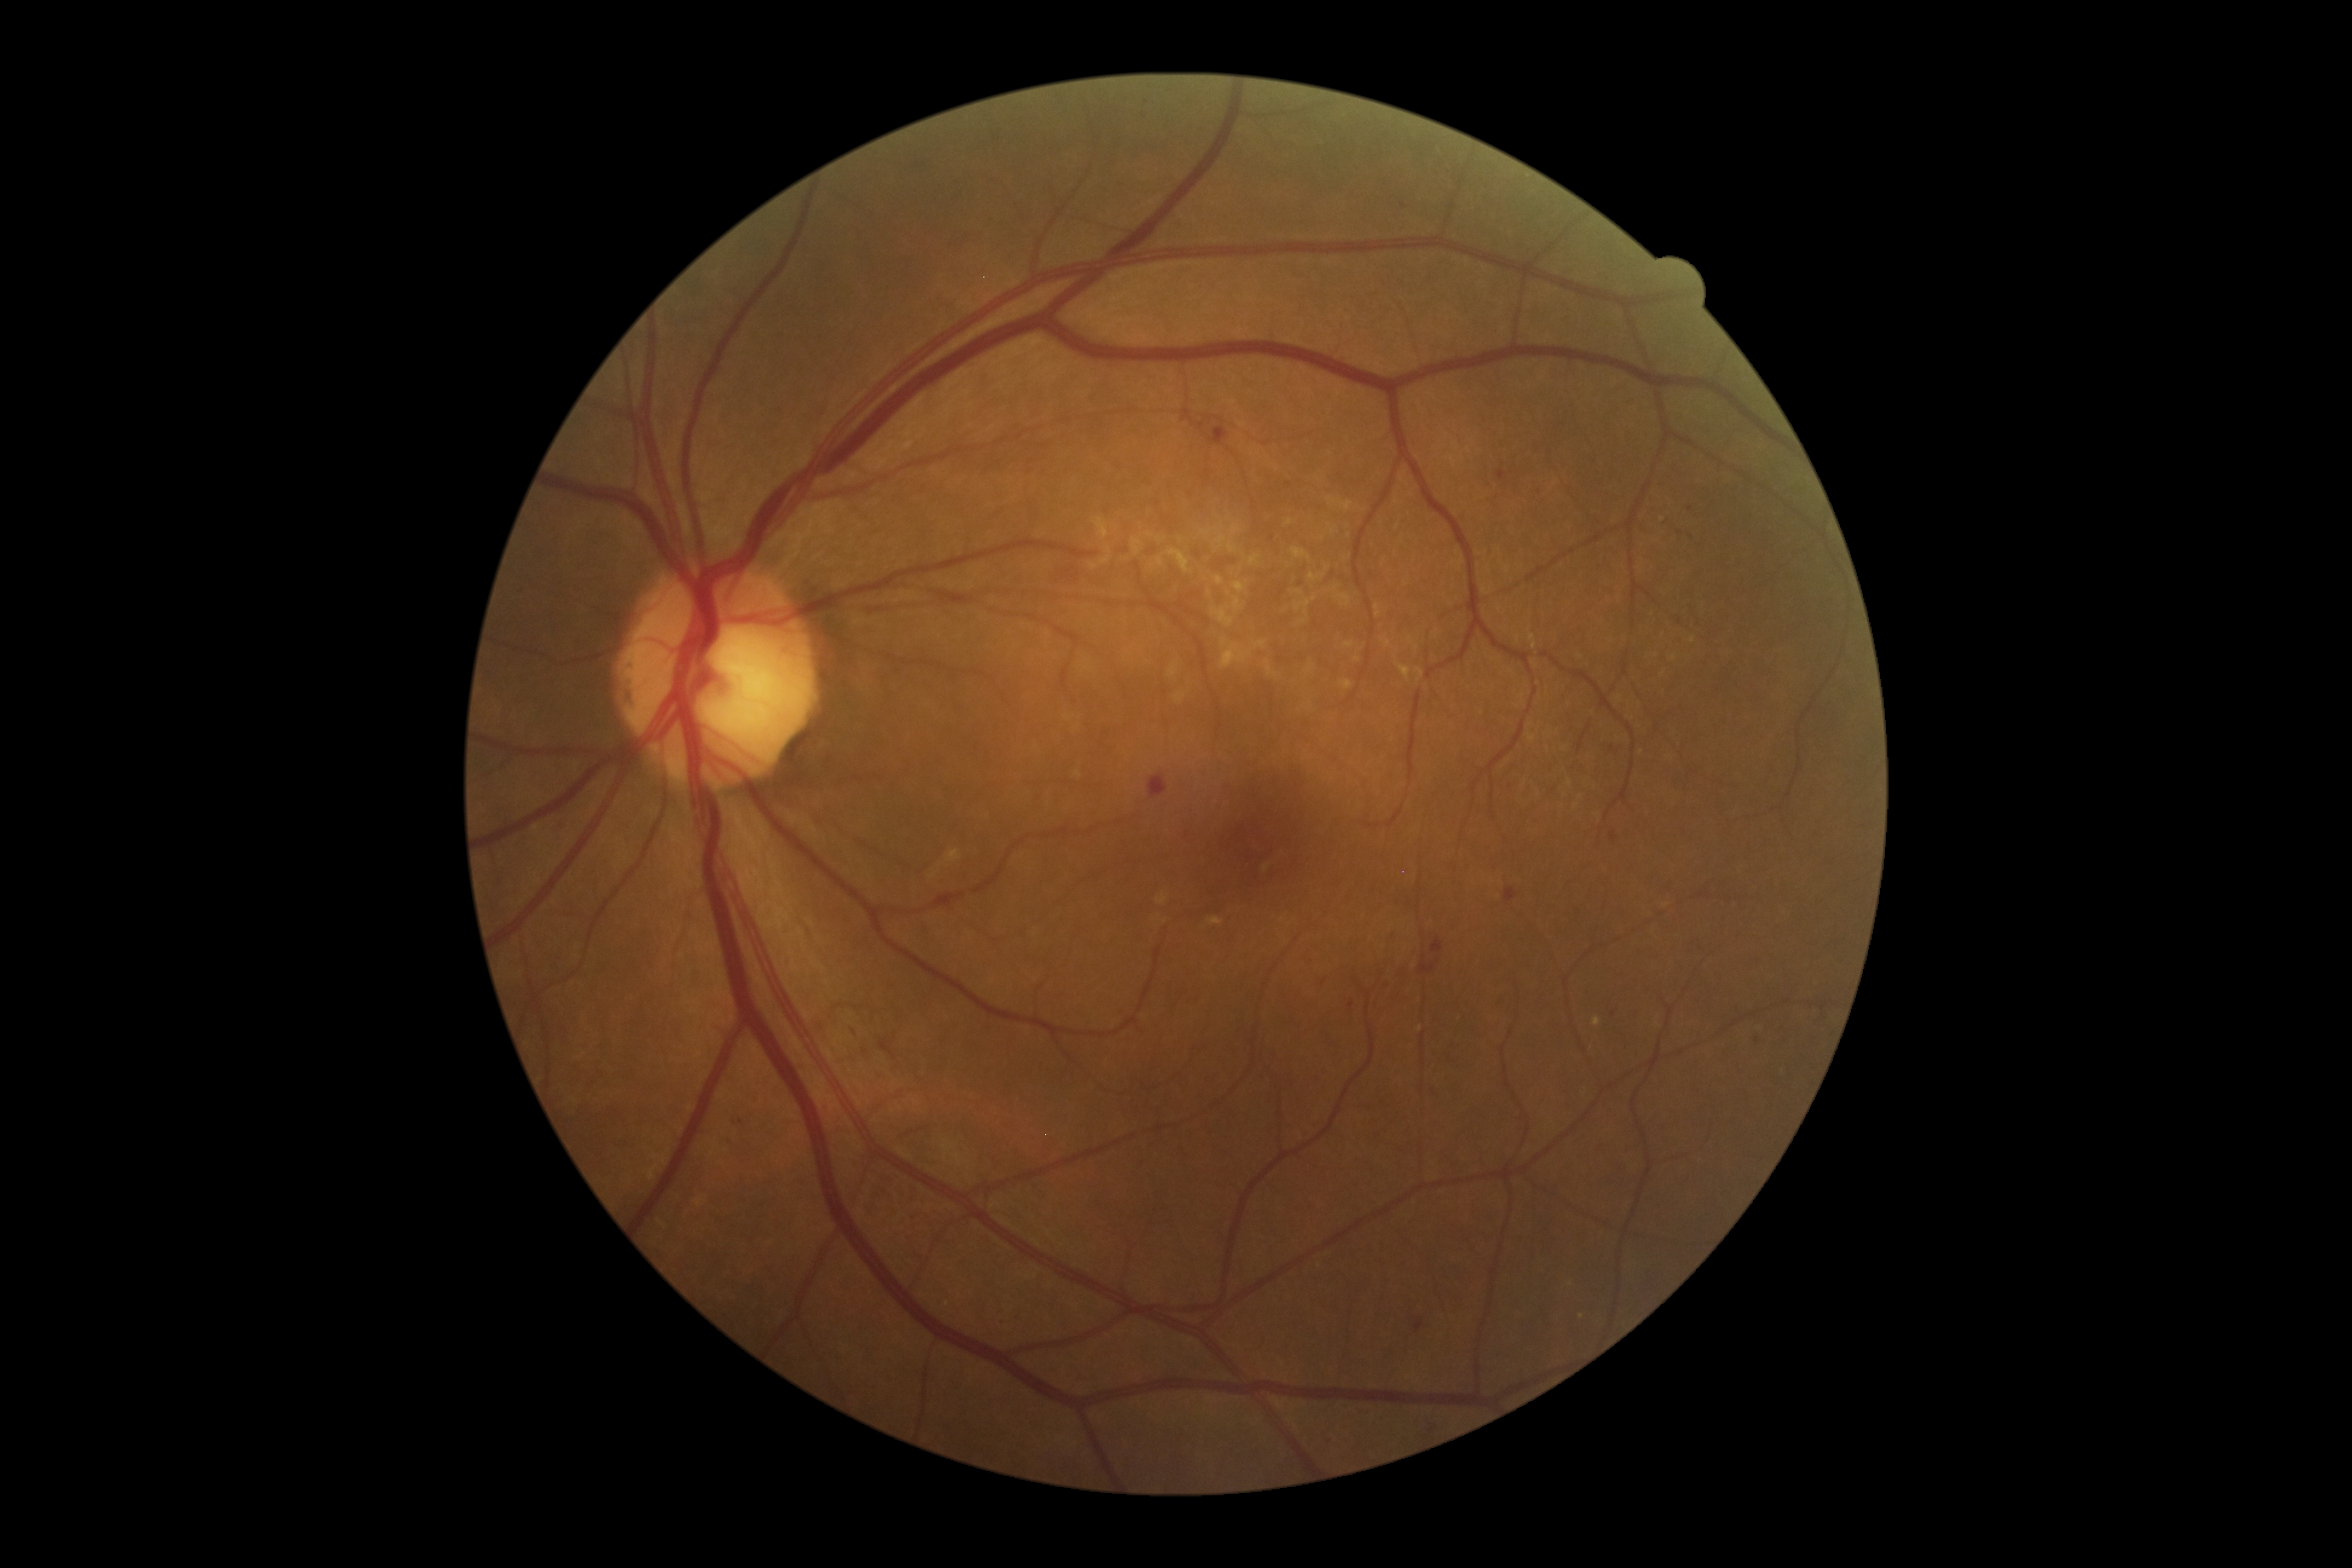
partial: true
dr_grade: 2
dr_grade_name: moderate NPDR
lesions:
  he:
    - x1=1420 y1=954 x2=1439 y2=973
    - x1=1208 y1=425 x2=1229 y2=445
    - x1=1428 y1=1086 x2=1448 y2=1099
    - x1=1751 y1=1035 x2=1763 y2=1045
    - x1=1504 y1=887 x2=1517 y2=903
    - x1=1148 y1=773 x2=1167 y2=798
    - x1=1385 y1=927 x2=1399 y2=941
    - x1=1496 y1=470 x2=1506 y2=481
  he_small:
    - [x=853, y=1031]
    - [x=1612, y=748]
    - [x=1690, y=509]
    - [x=1403, y=206]